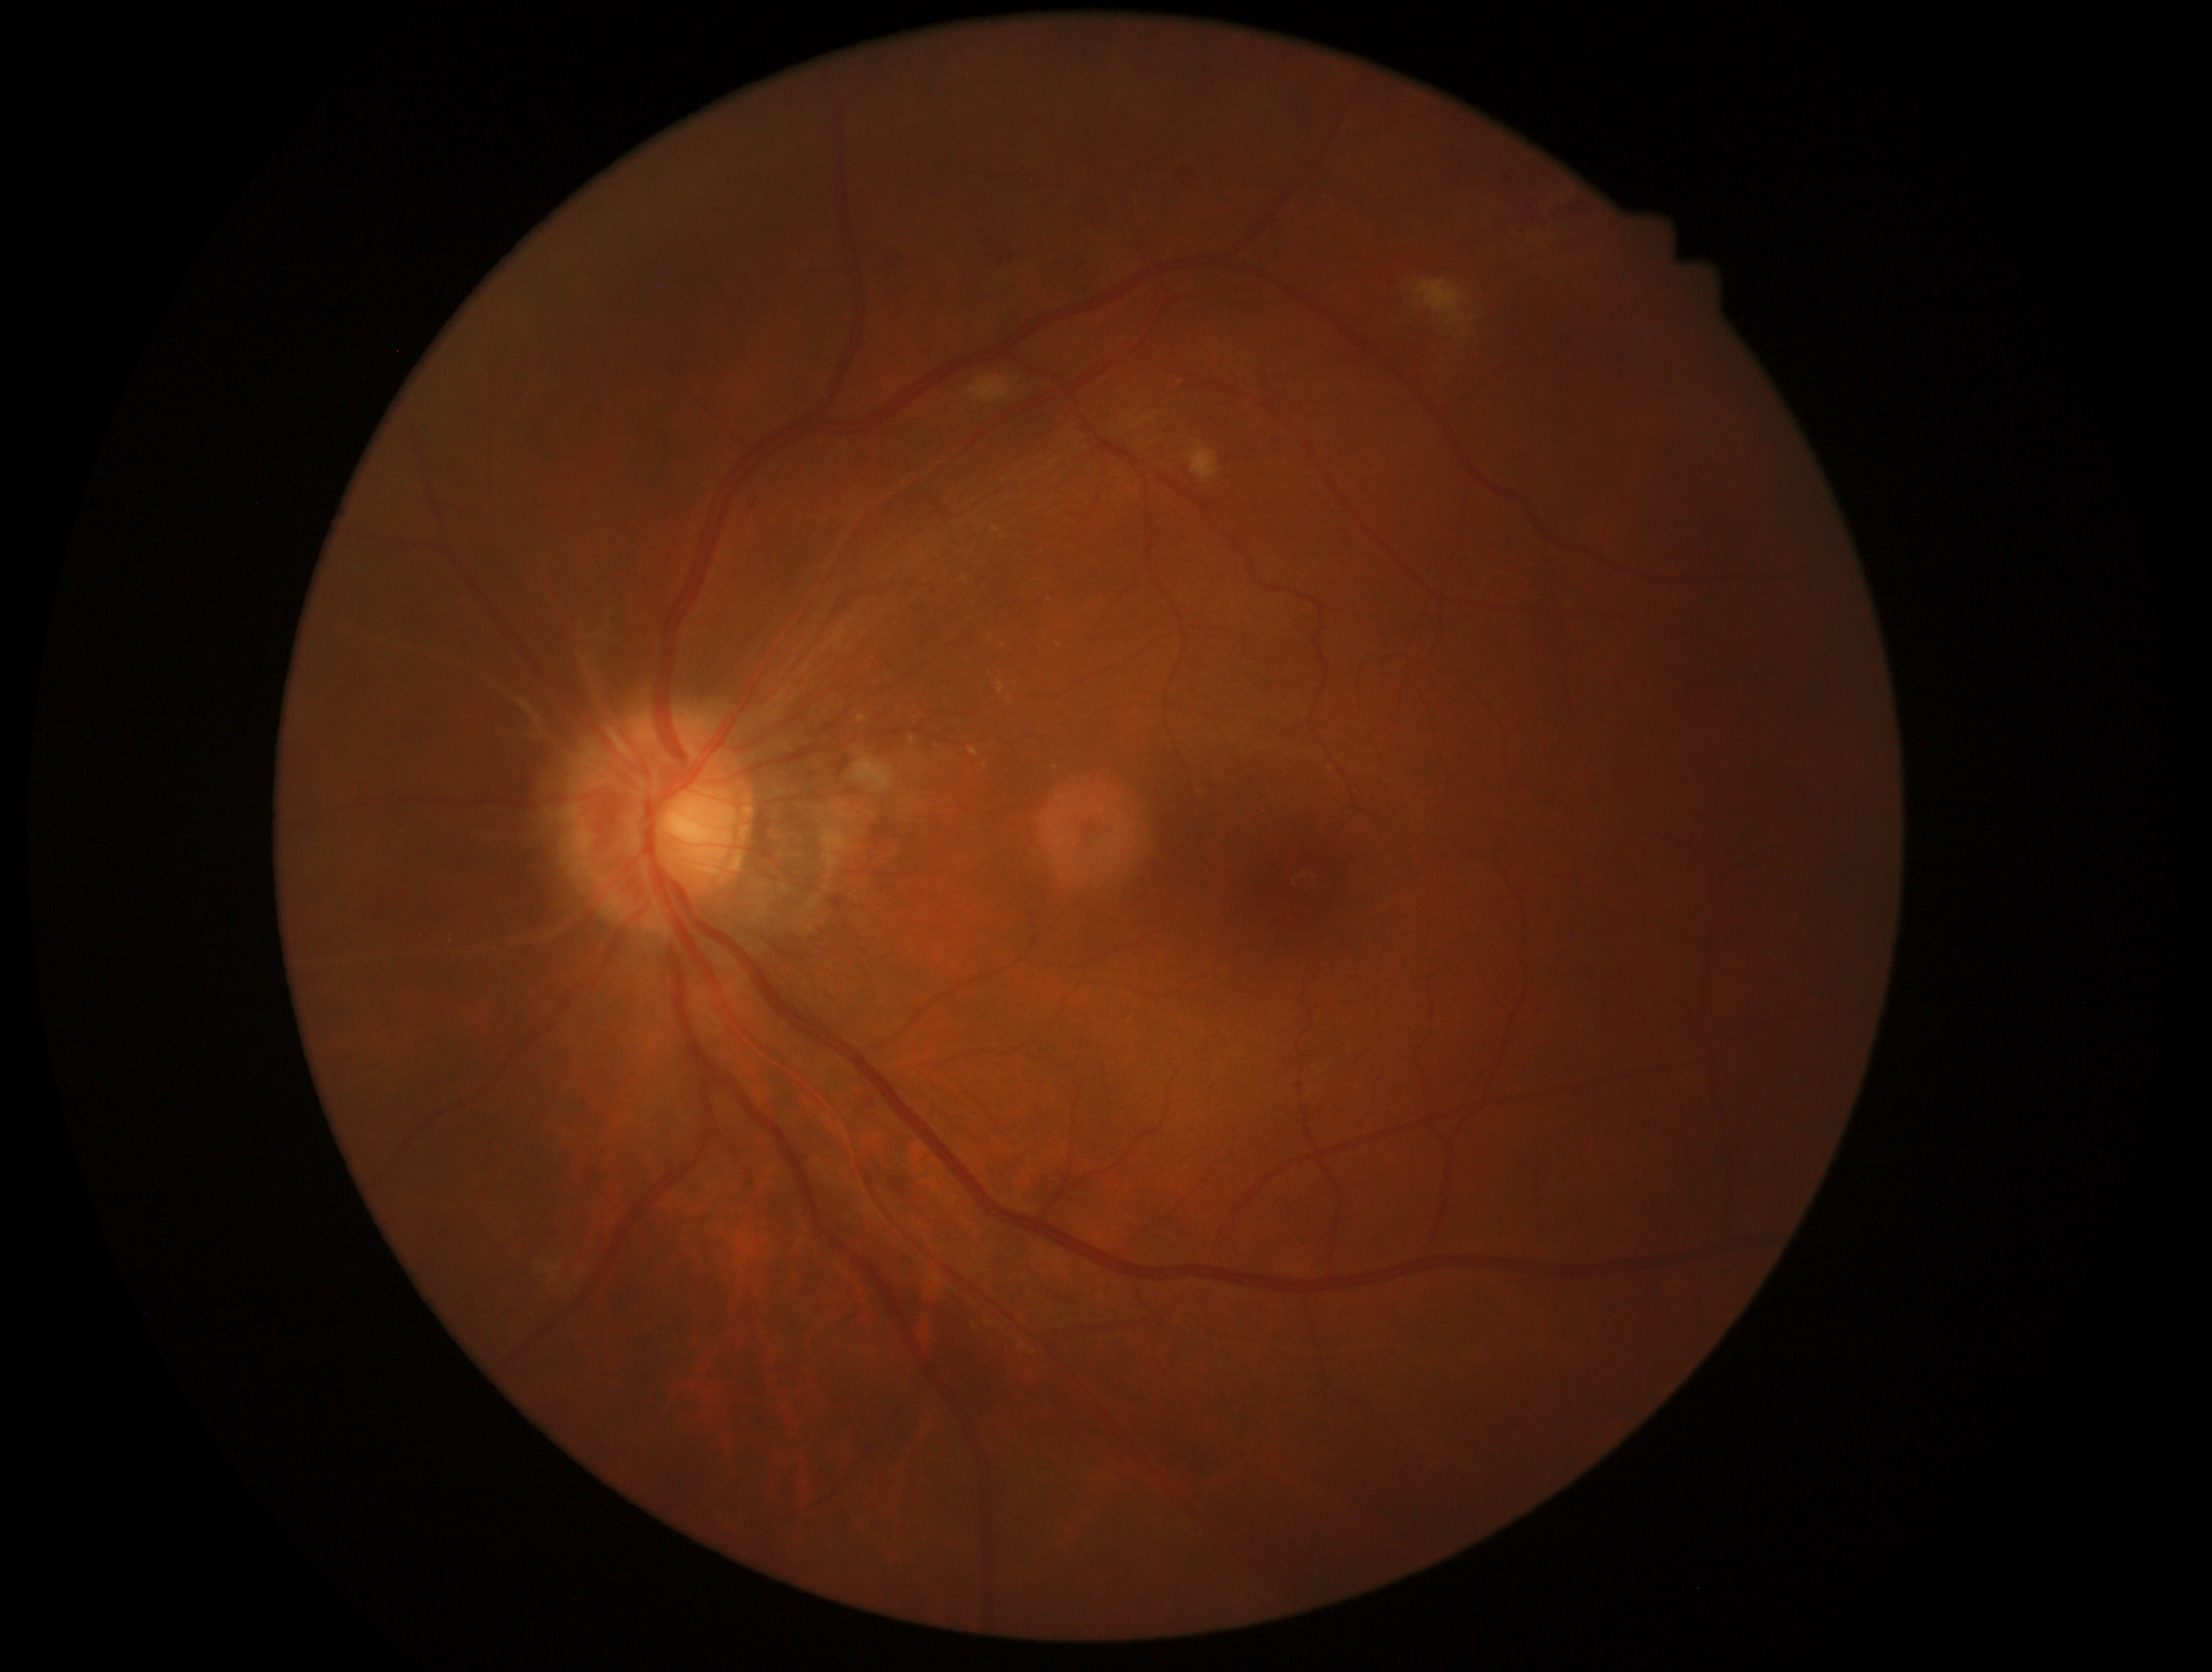
The retinopathy is classified as non-proliferative diabetic retinopathy. DR severity is moderate non-proliferative diabetic retinopathy (grade 2) — more than just microaneurysms but less than severe NPDR.